848 by 848 pixels — 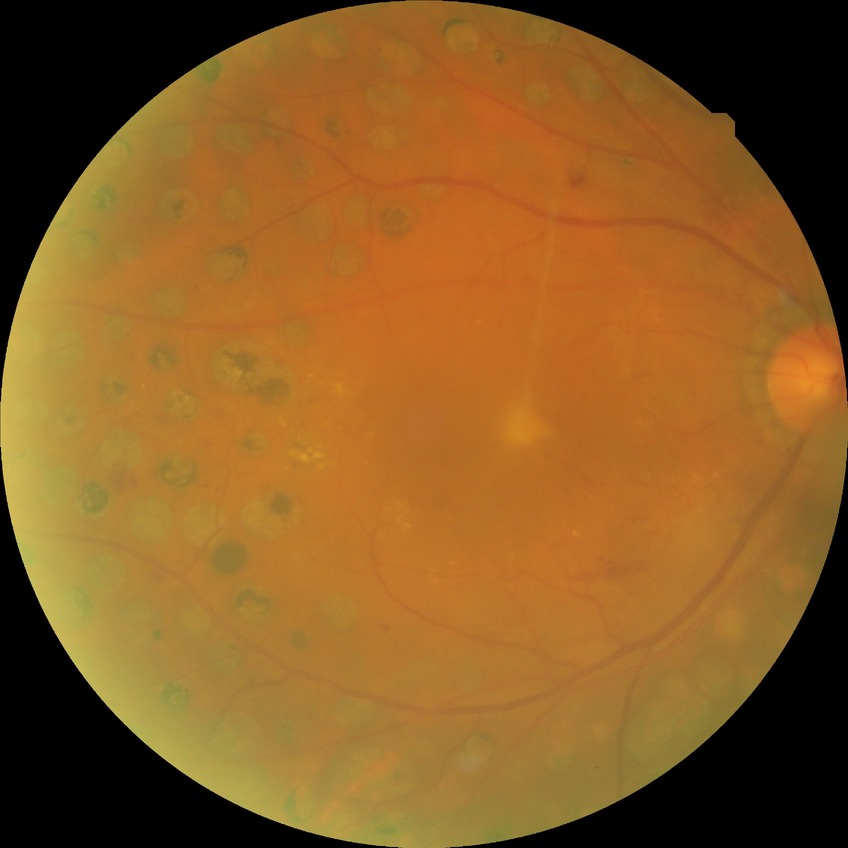

DR grade=PDR.